45 degree fundus photograph · acquired with a NIDEK AFC-230 · no pharmacologic dilation · posterior pole photograph · 848 x 848 pixels
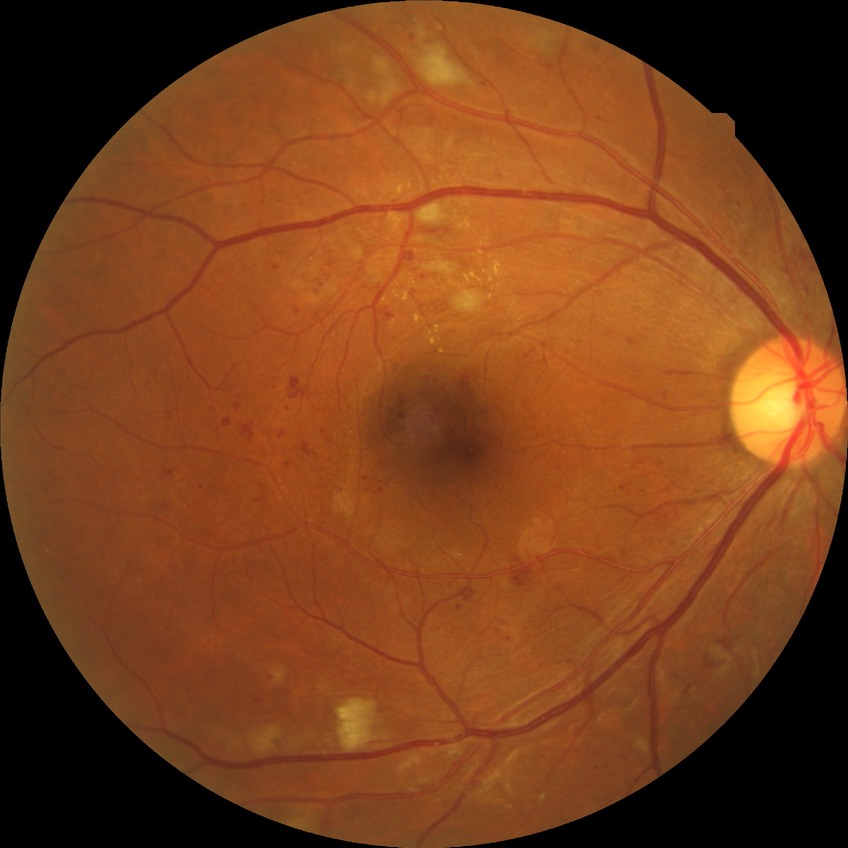 Disease class: non-proliferative diabetic retinopathy. Diabetic retinopathy (DR) is PPDR (pre-proliferative diabetic retinopathy).